2346x1568; 45° field of view; fundus photo
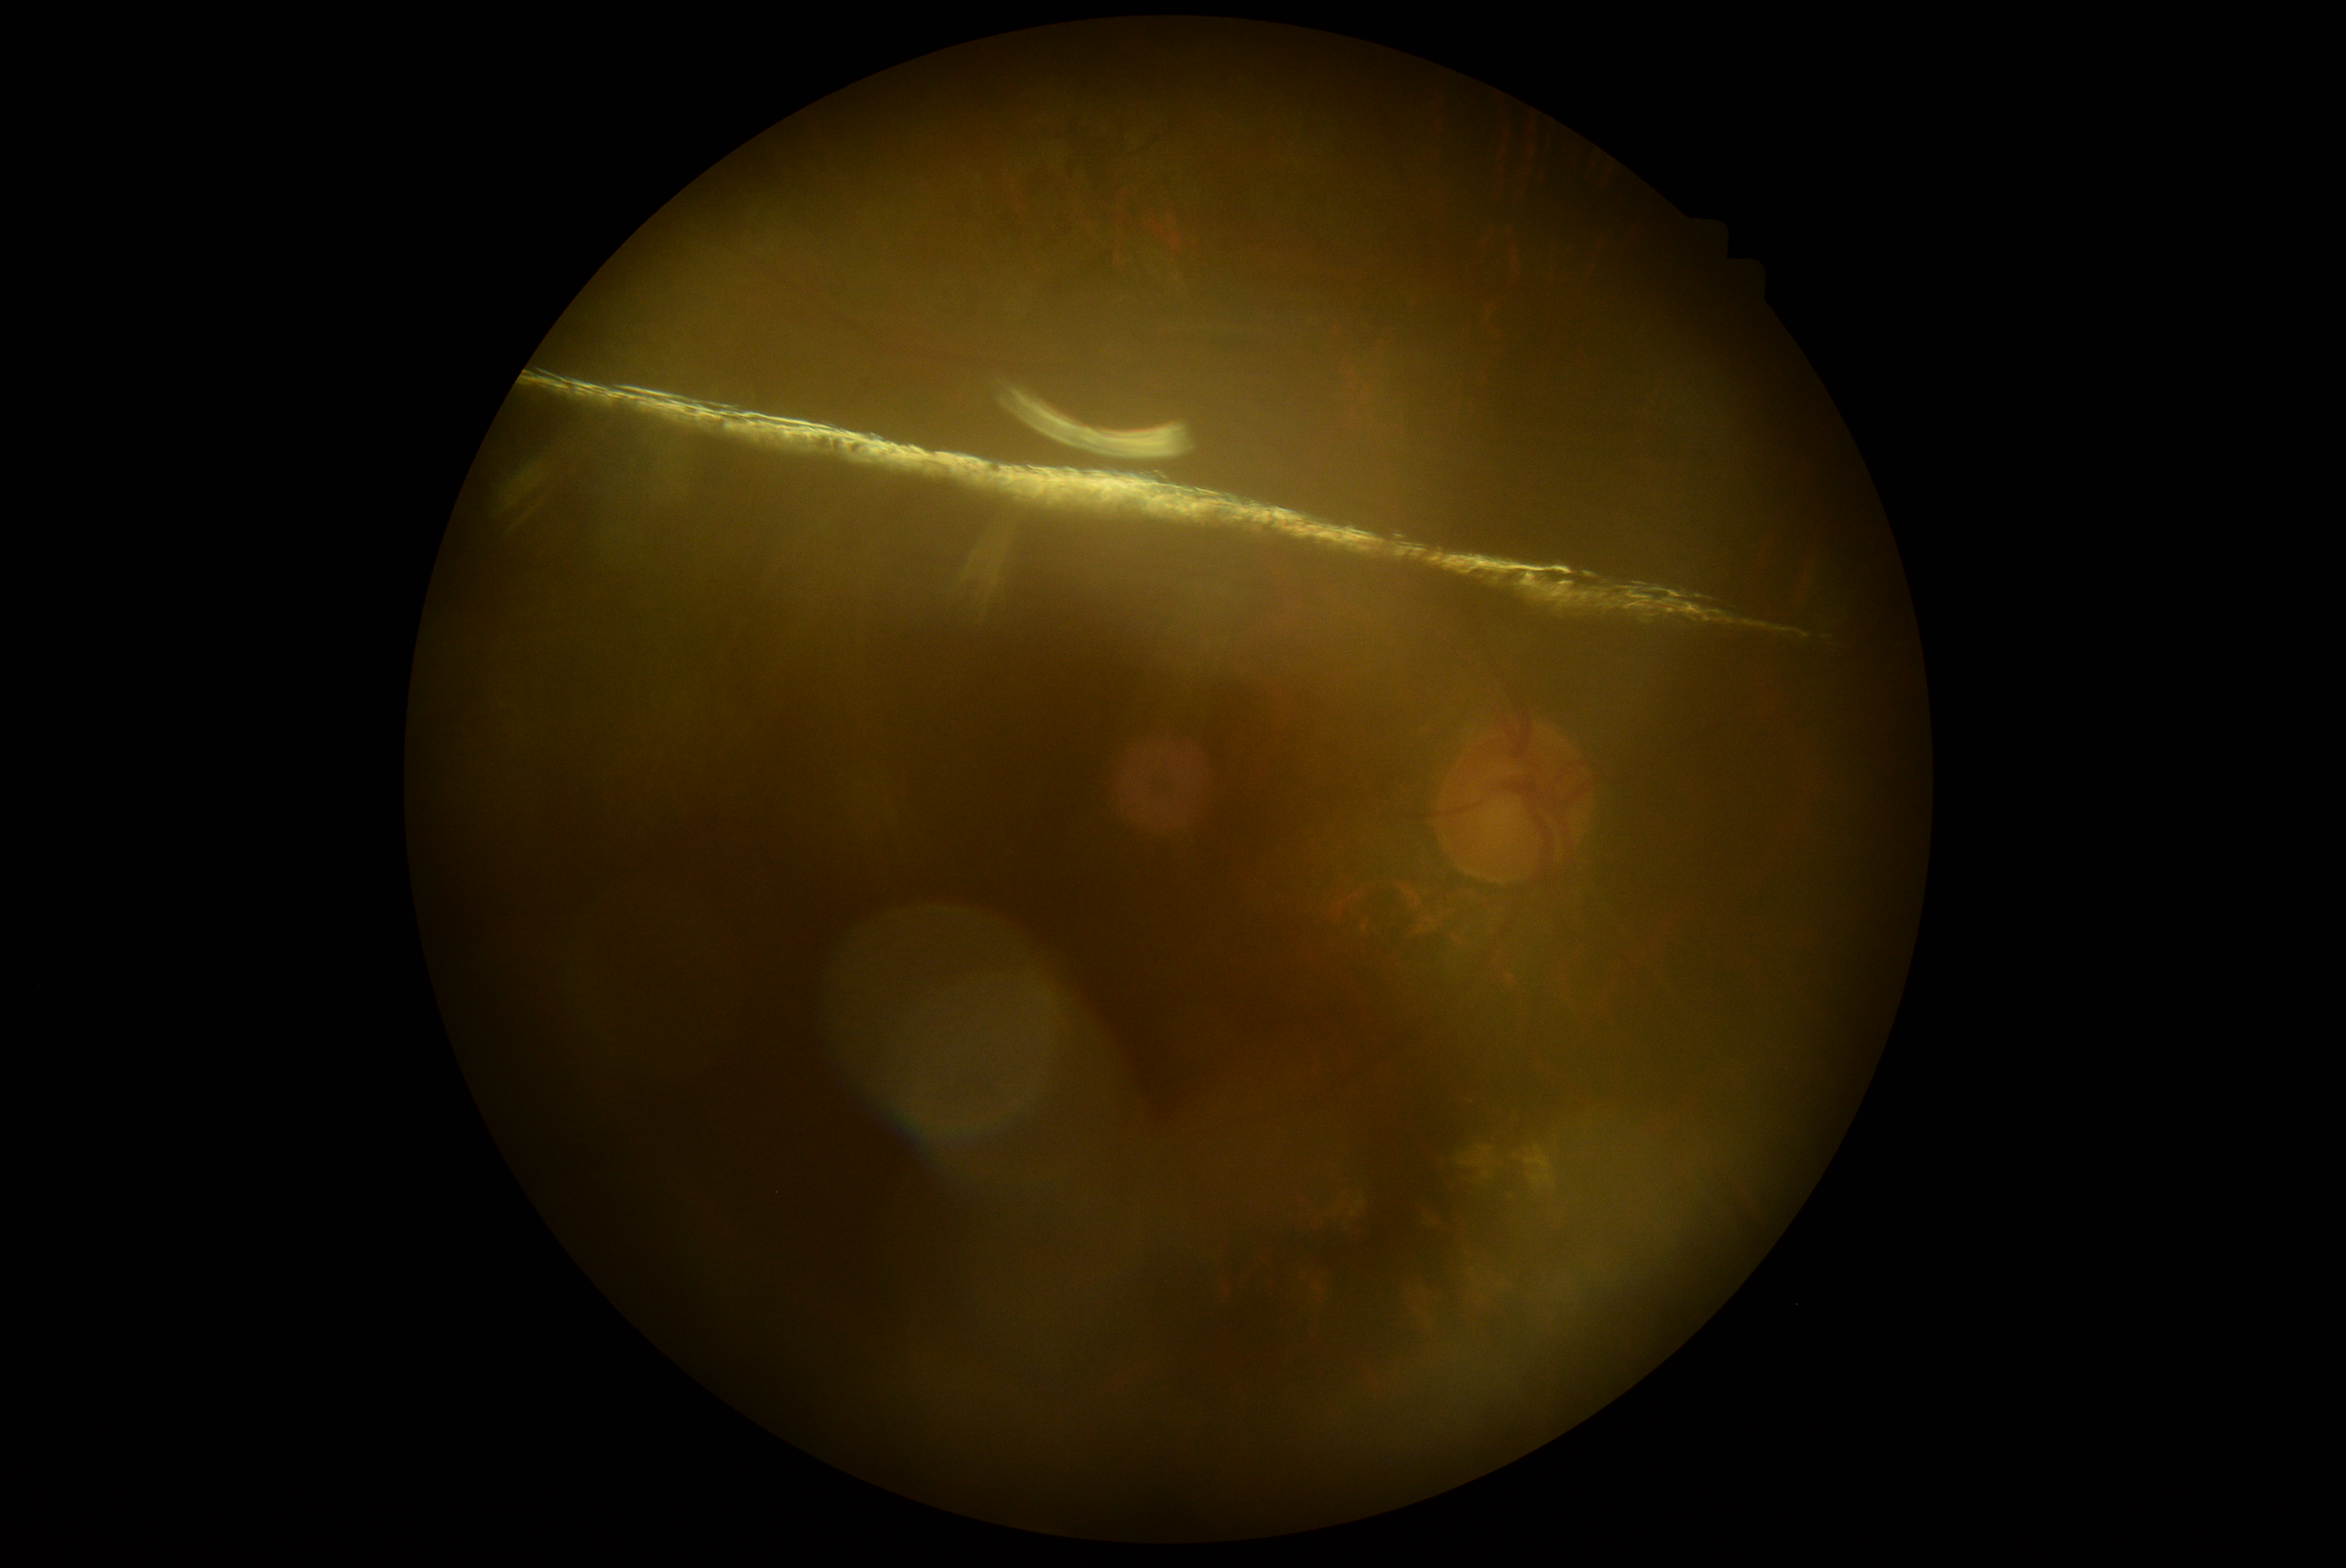

DR severity is ungradable.